Pediatric retinal photograph (wide-field). Captured with the Phoenix ICON (100° field of view). Image size 1240x1240.
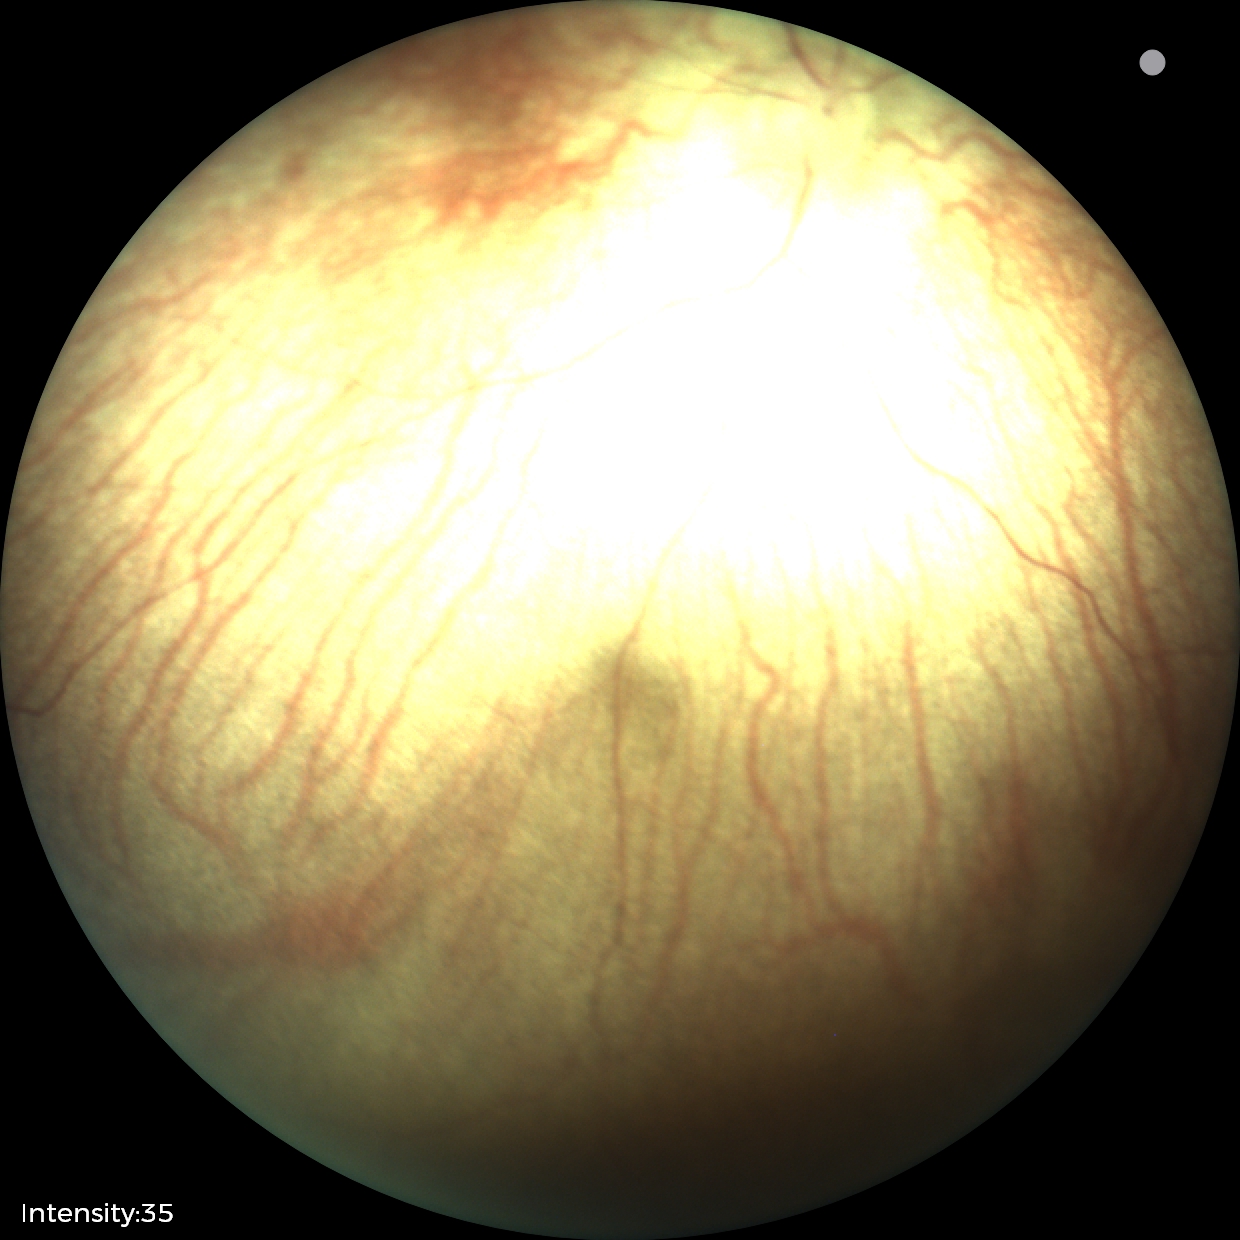 Impression: normal retinal appearance.